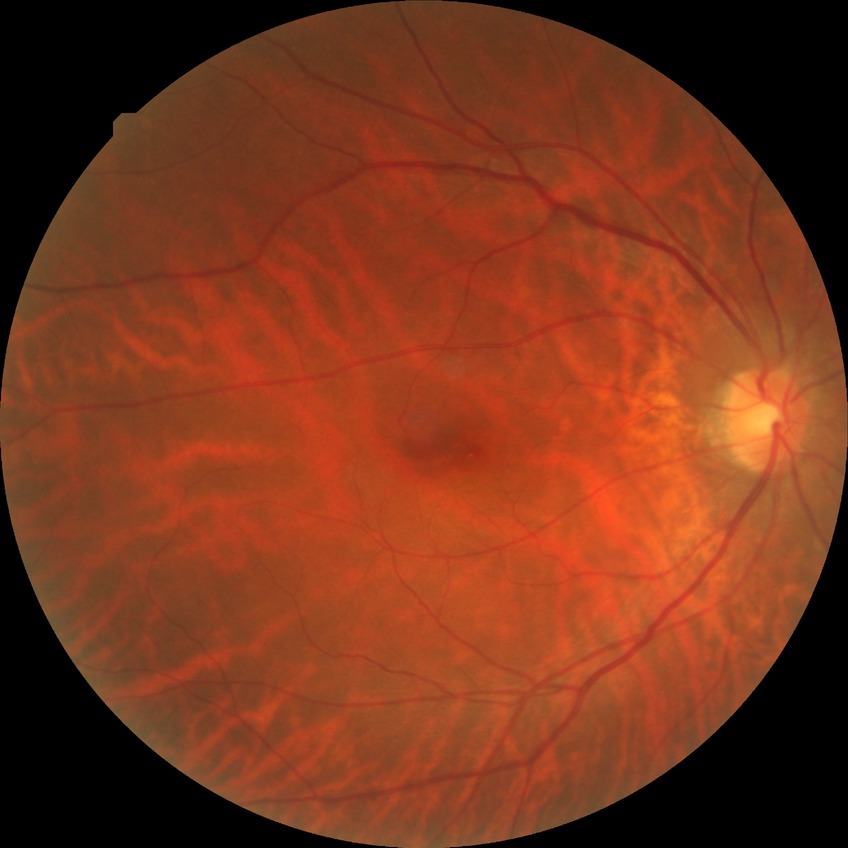

{
  "davis_grade": "no diabetic retinopathy (NDR)"
}